45° field of view, modified Davis classification: 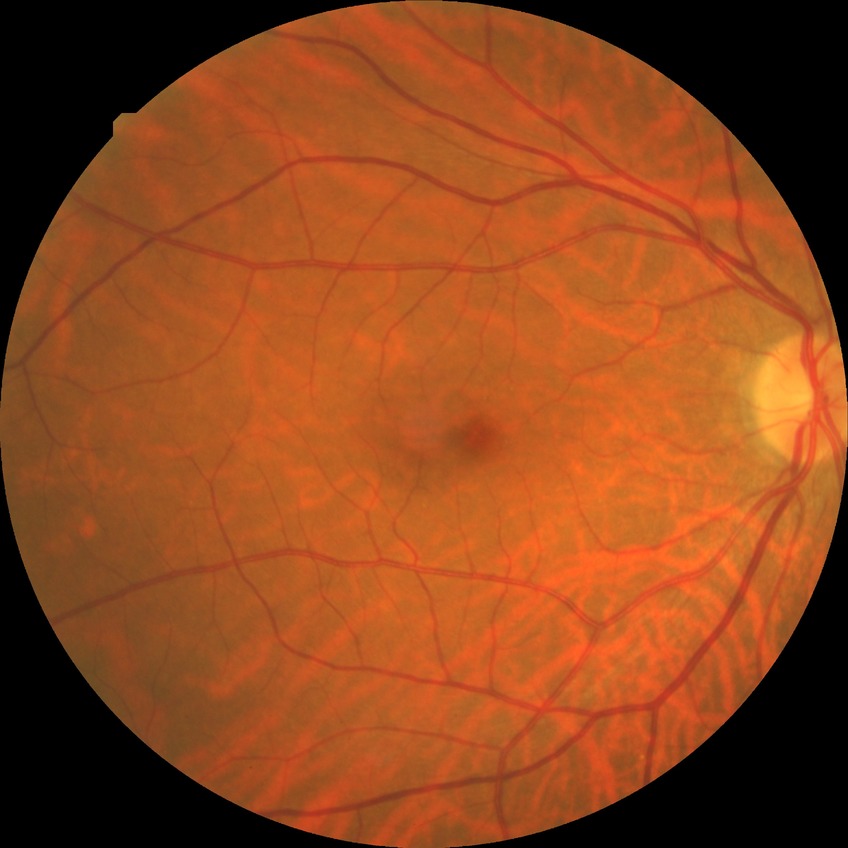

diabetic retinopathy (DR) = no diabetic retinopathy (NDR).